Wide-field fundus image from infant ROP screening — 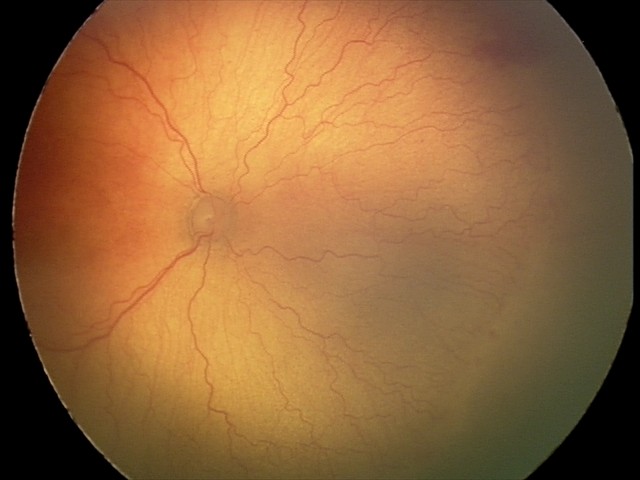

Q: What is the screening diagnosis?
A: aggressive retinopathy of prematurity — rapidly progressive severe ROP with prominent plus disease, often without classic stage progression
Q: Is plus disease present?
A: plus disease